2352x1568px; color fundus image; 45° field of view.
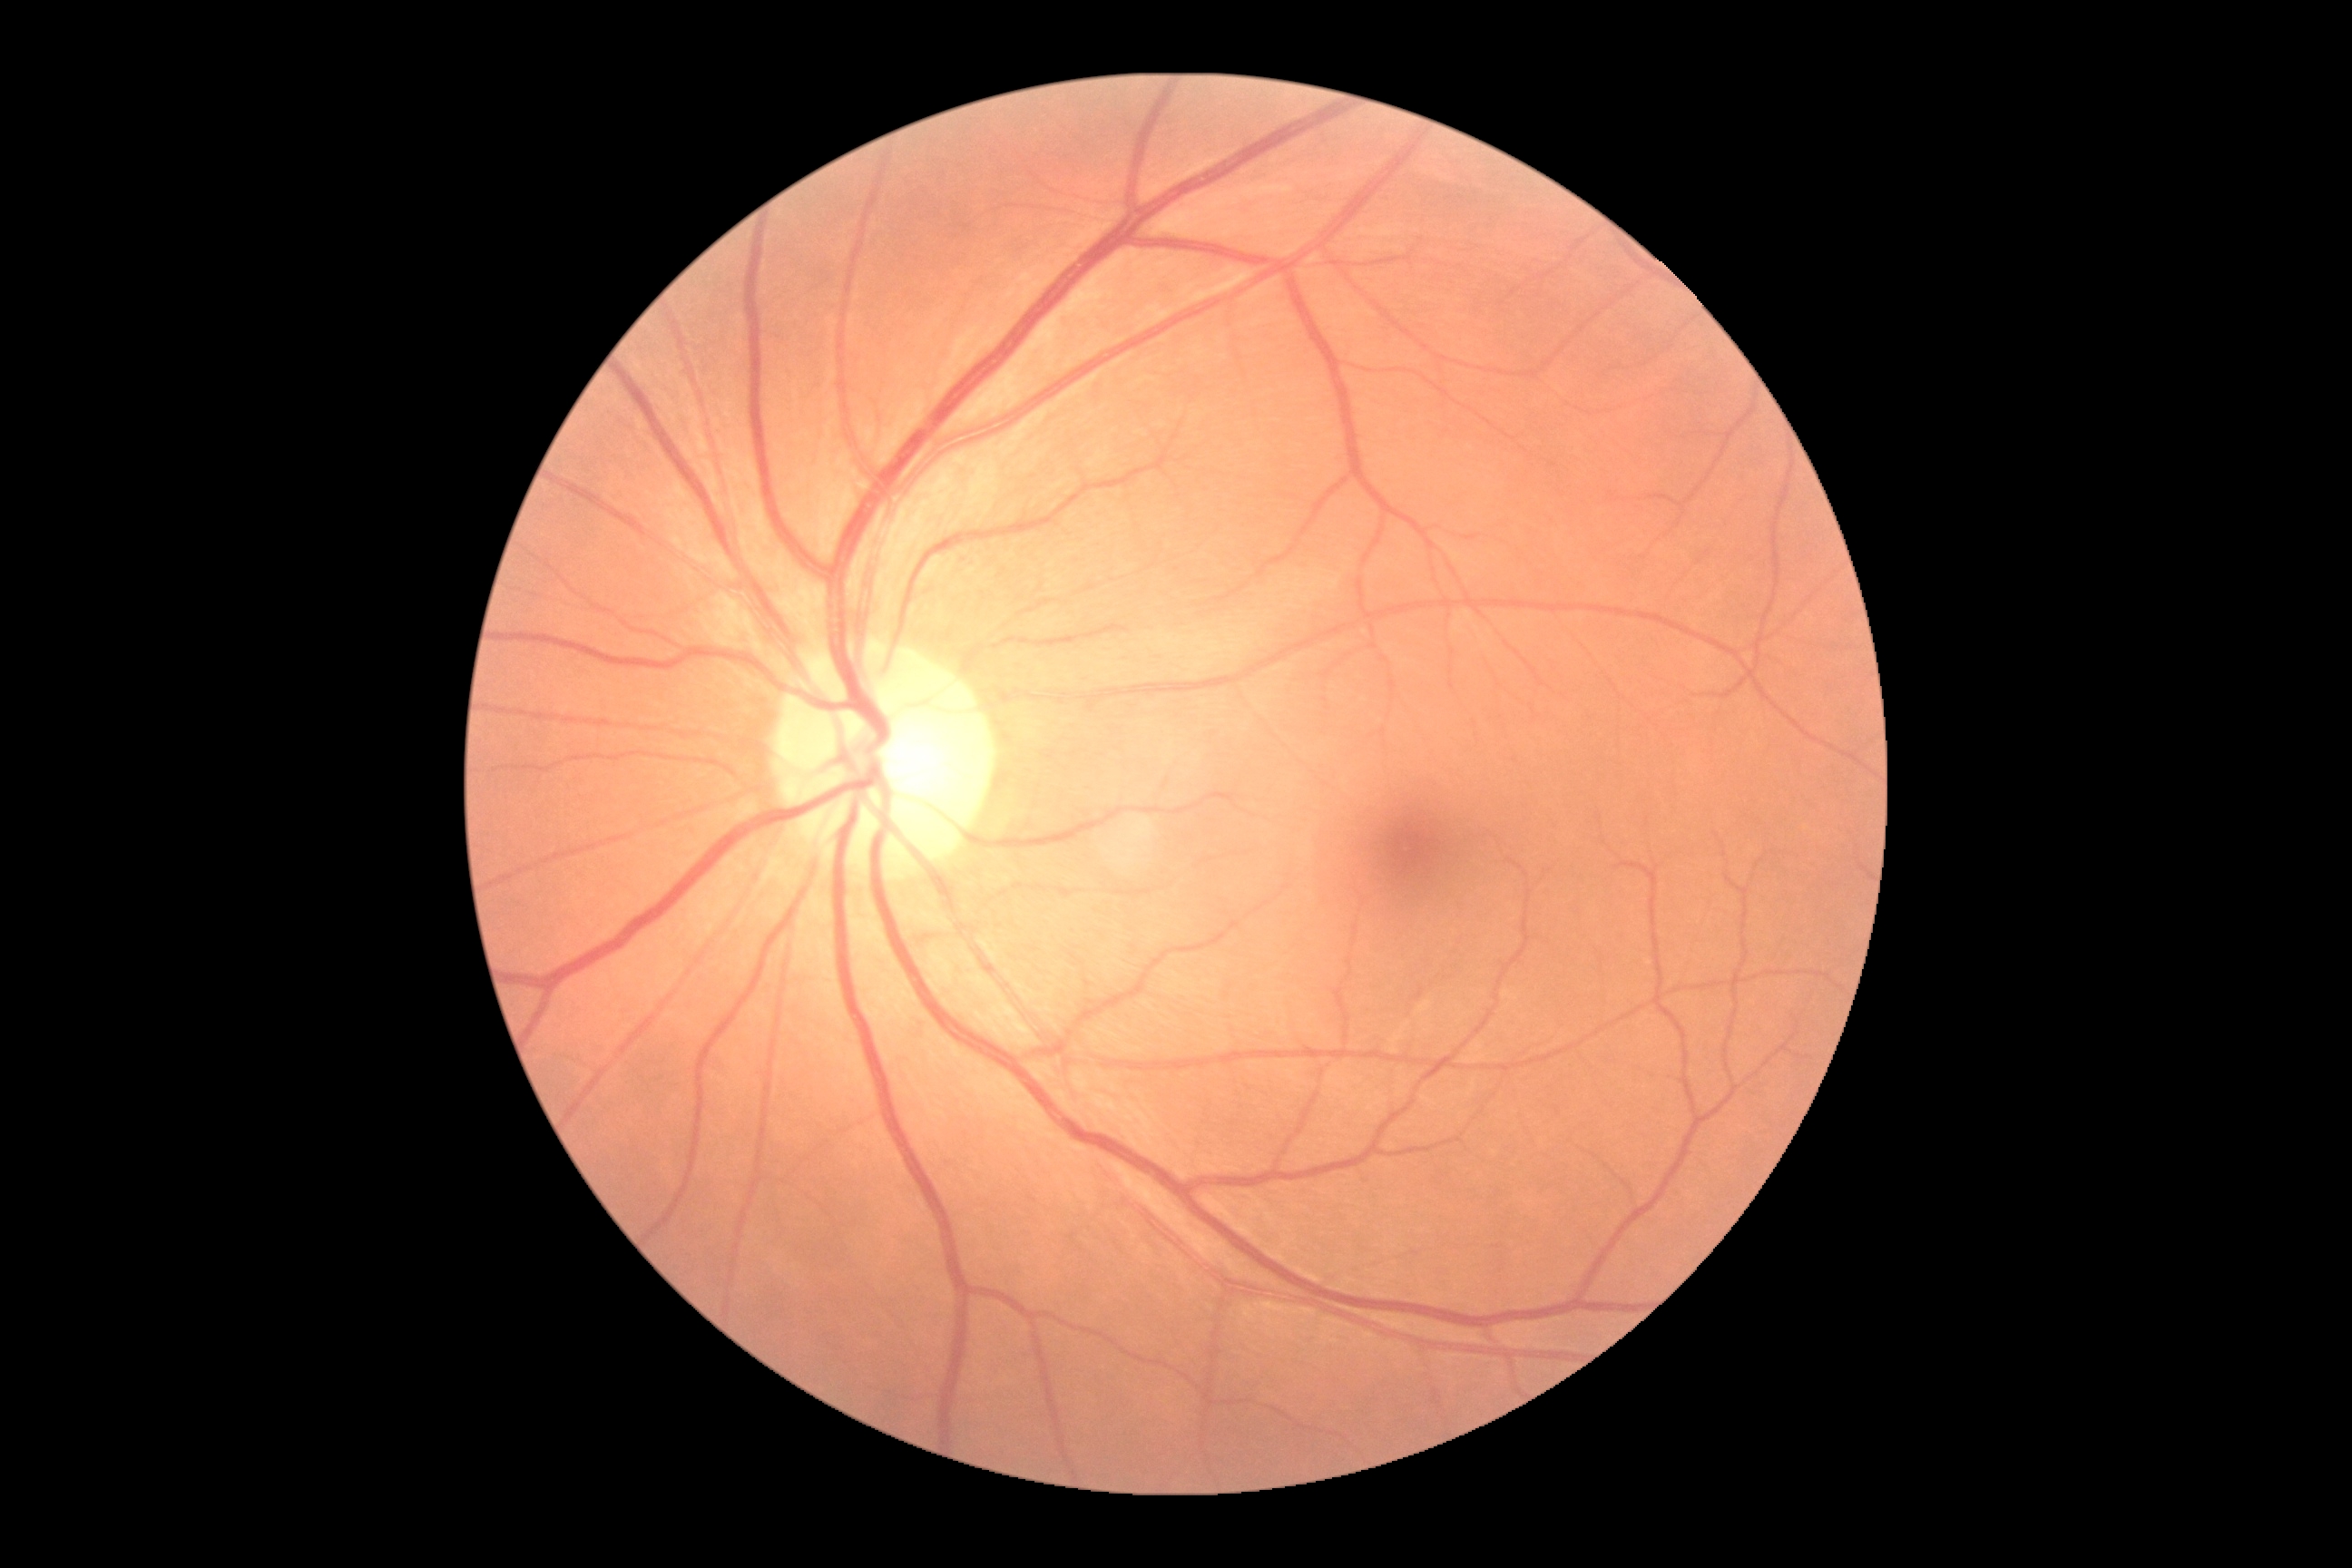

DR stage is grade 0.